Tabletop color fundus camera image — 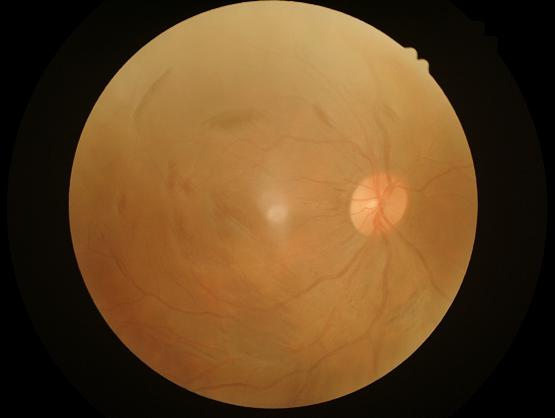
Quality grading: contrast: narrow intensity range, structures hard to distinguish | overall: poor, ungradable | clarity: reduced sharpness with visible blur | illumination: even and well-balanced.